Fundus photo. Image size 848x848.
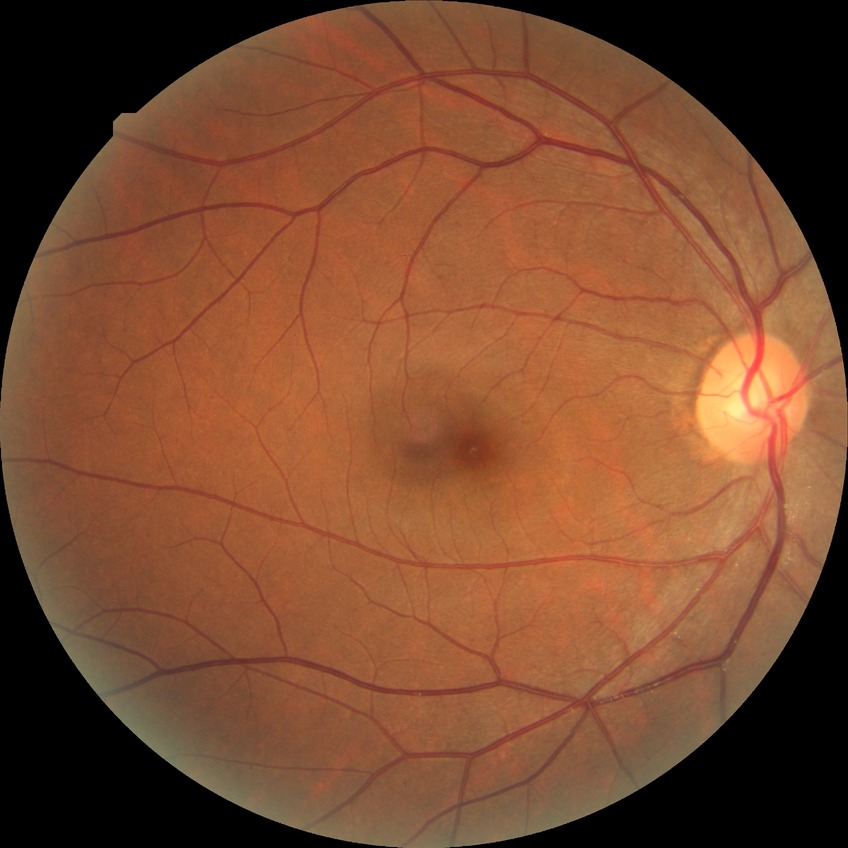 davis_grade: no diabetic retinopathy